848 x 848 pixels · fundus photo · graded on the modified Davis scale · without pupil dilation · FOV: 45 degrees · camera: NIDEK AFC-230:
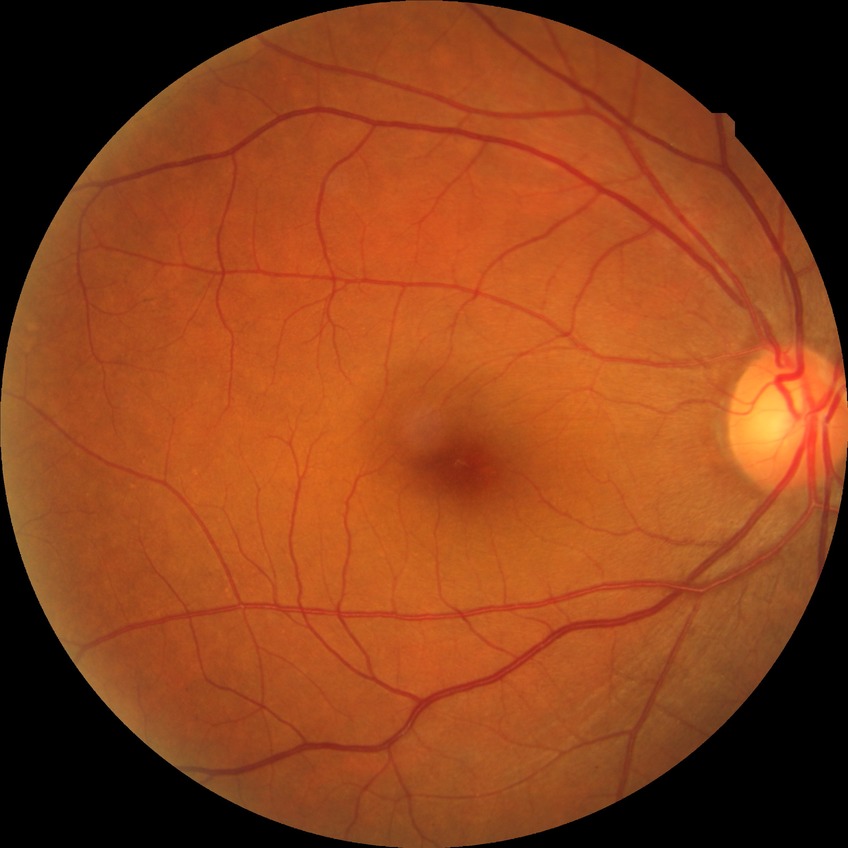

Annotations:
• diabetic retinopathy (DR) — no diabetic retinopathy (NDR)